Color fundus image. Optic nerve head crop: 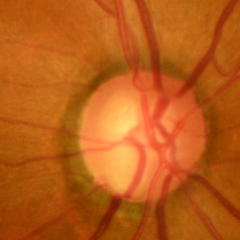

The image shows early glaucomatous optic neuropathy.